1440 by 1080 pixels. 130° field of view (Natus RetCam Envision). Wide-field contact fundus photograph of an infant
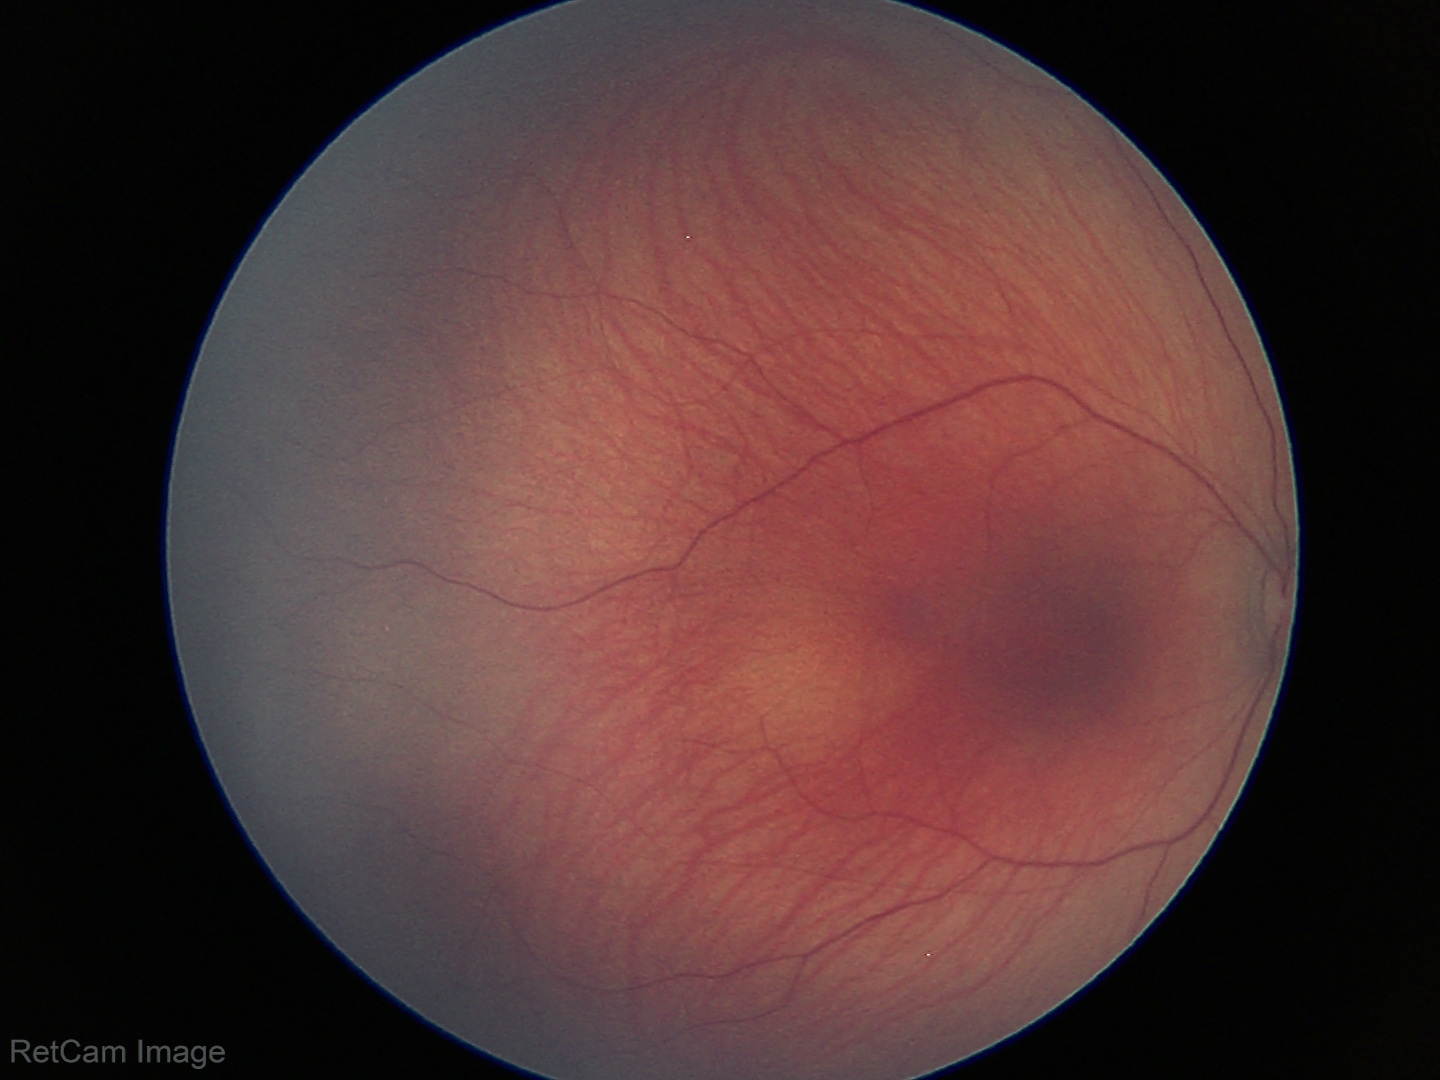 Diagnosis: physiological.